Infant wide-field retinal image · Clarity RetCam 3, 130° FOV
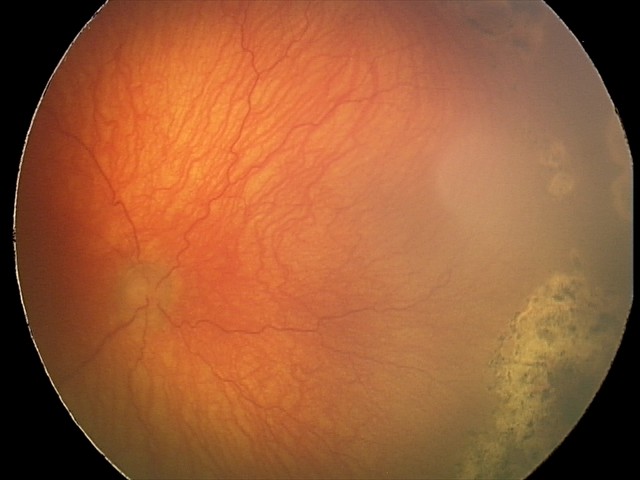

Screening diagnosis: plus disease | aggressive retinopathy of prematurity (A-ROP) — rapidly progressive severe ROP with prominent plus disease, often without classic stage progression.